Acquired with a NIDEK AFC-230. Image size 848x848. Color fundus image. Nonmydriatic fundus photograph.
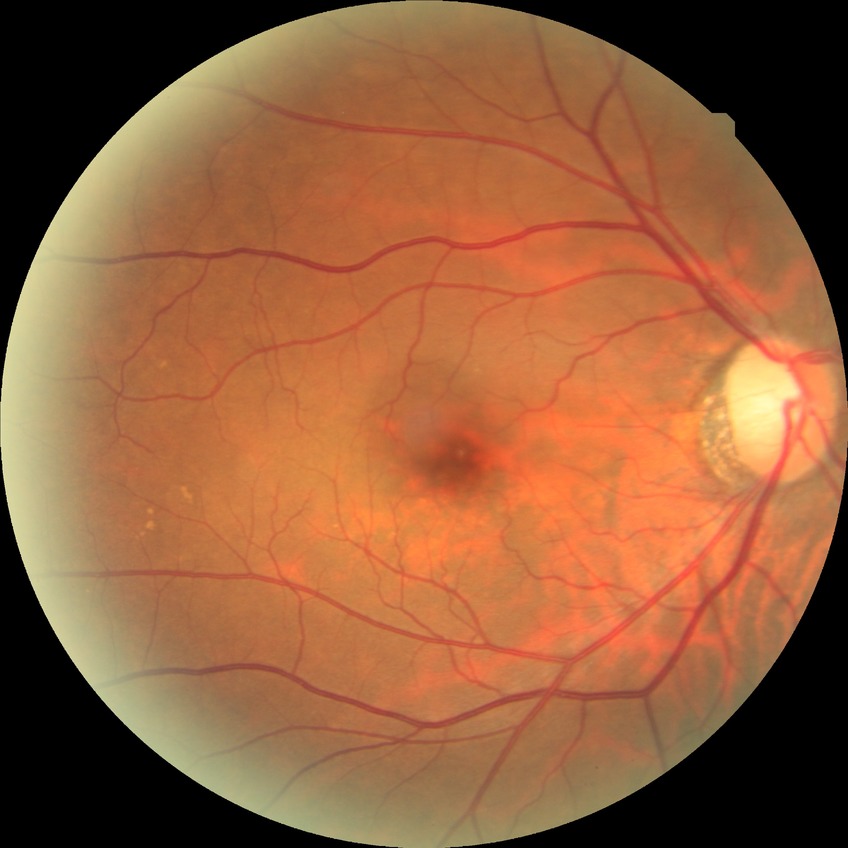 Davis grading: no diabetic retinopathy.